Captured on a Topcon TRC-NW8 fundus camera:
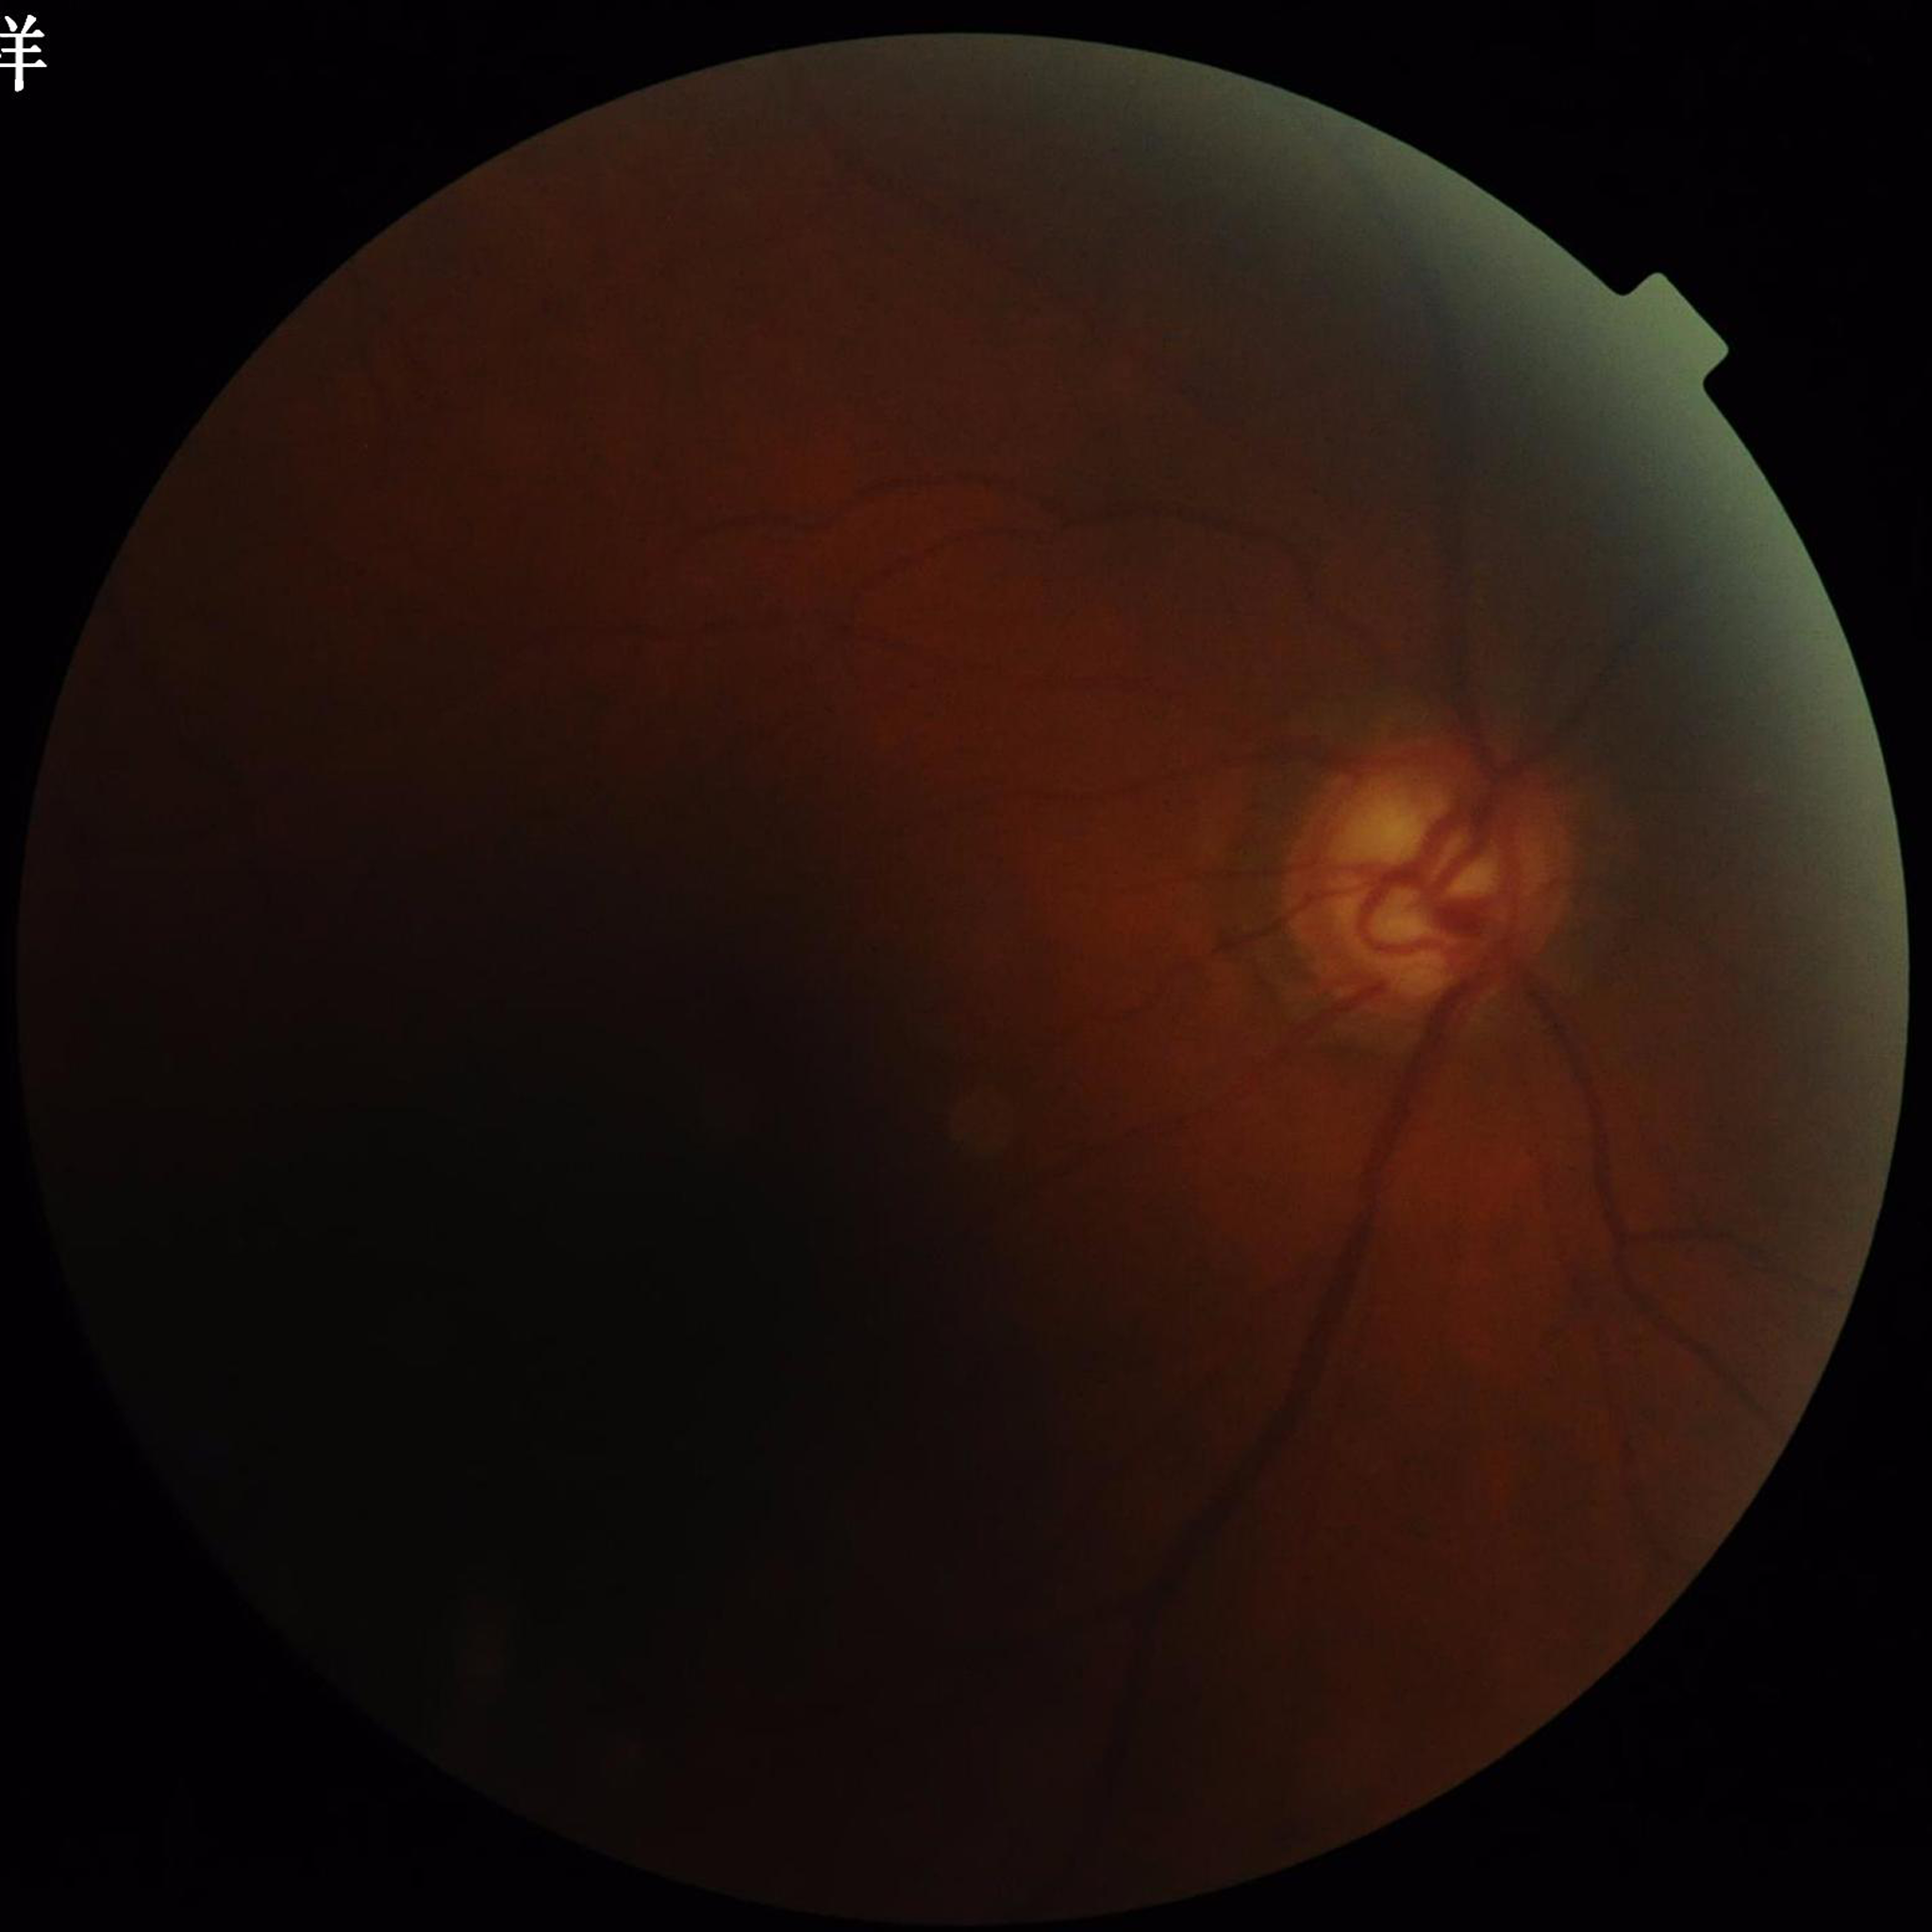
This fundus photograph is from a patient diagnosed with glaucoma. Image quality: low contrast, blur present, illumination/color distortion present.